130° field of view (Clarity RetCam 3) · wide-field contact fundus photograph of an infant · 640x480.
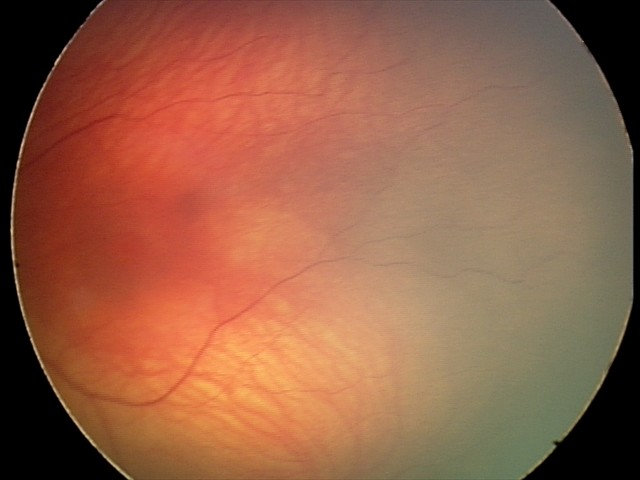
Screening examination with no abnormal retinal findings.